Wide-field retinal mosaic image. 200° FOV:
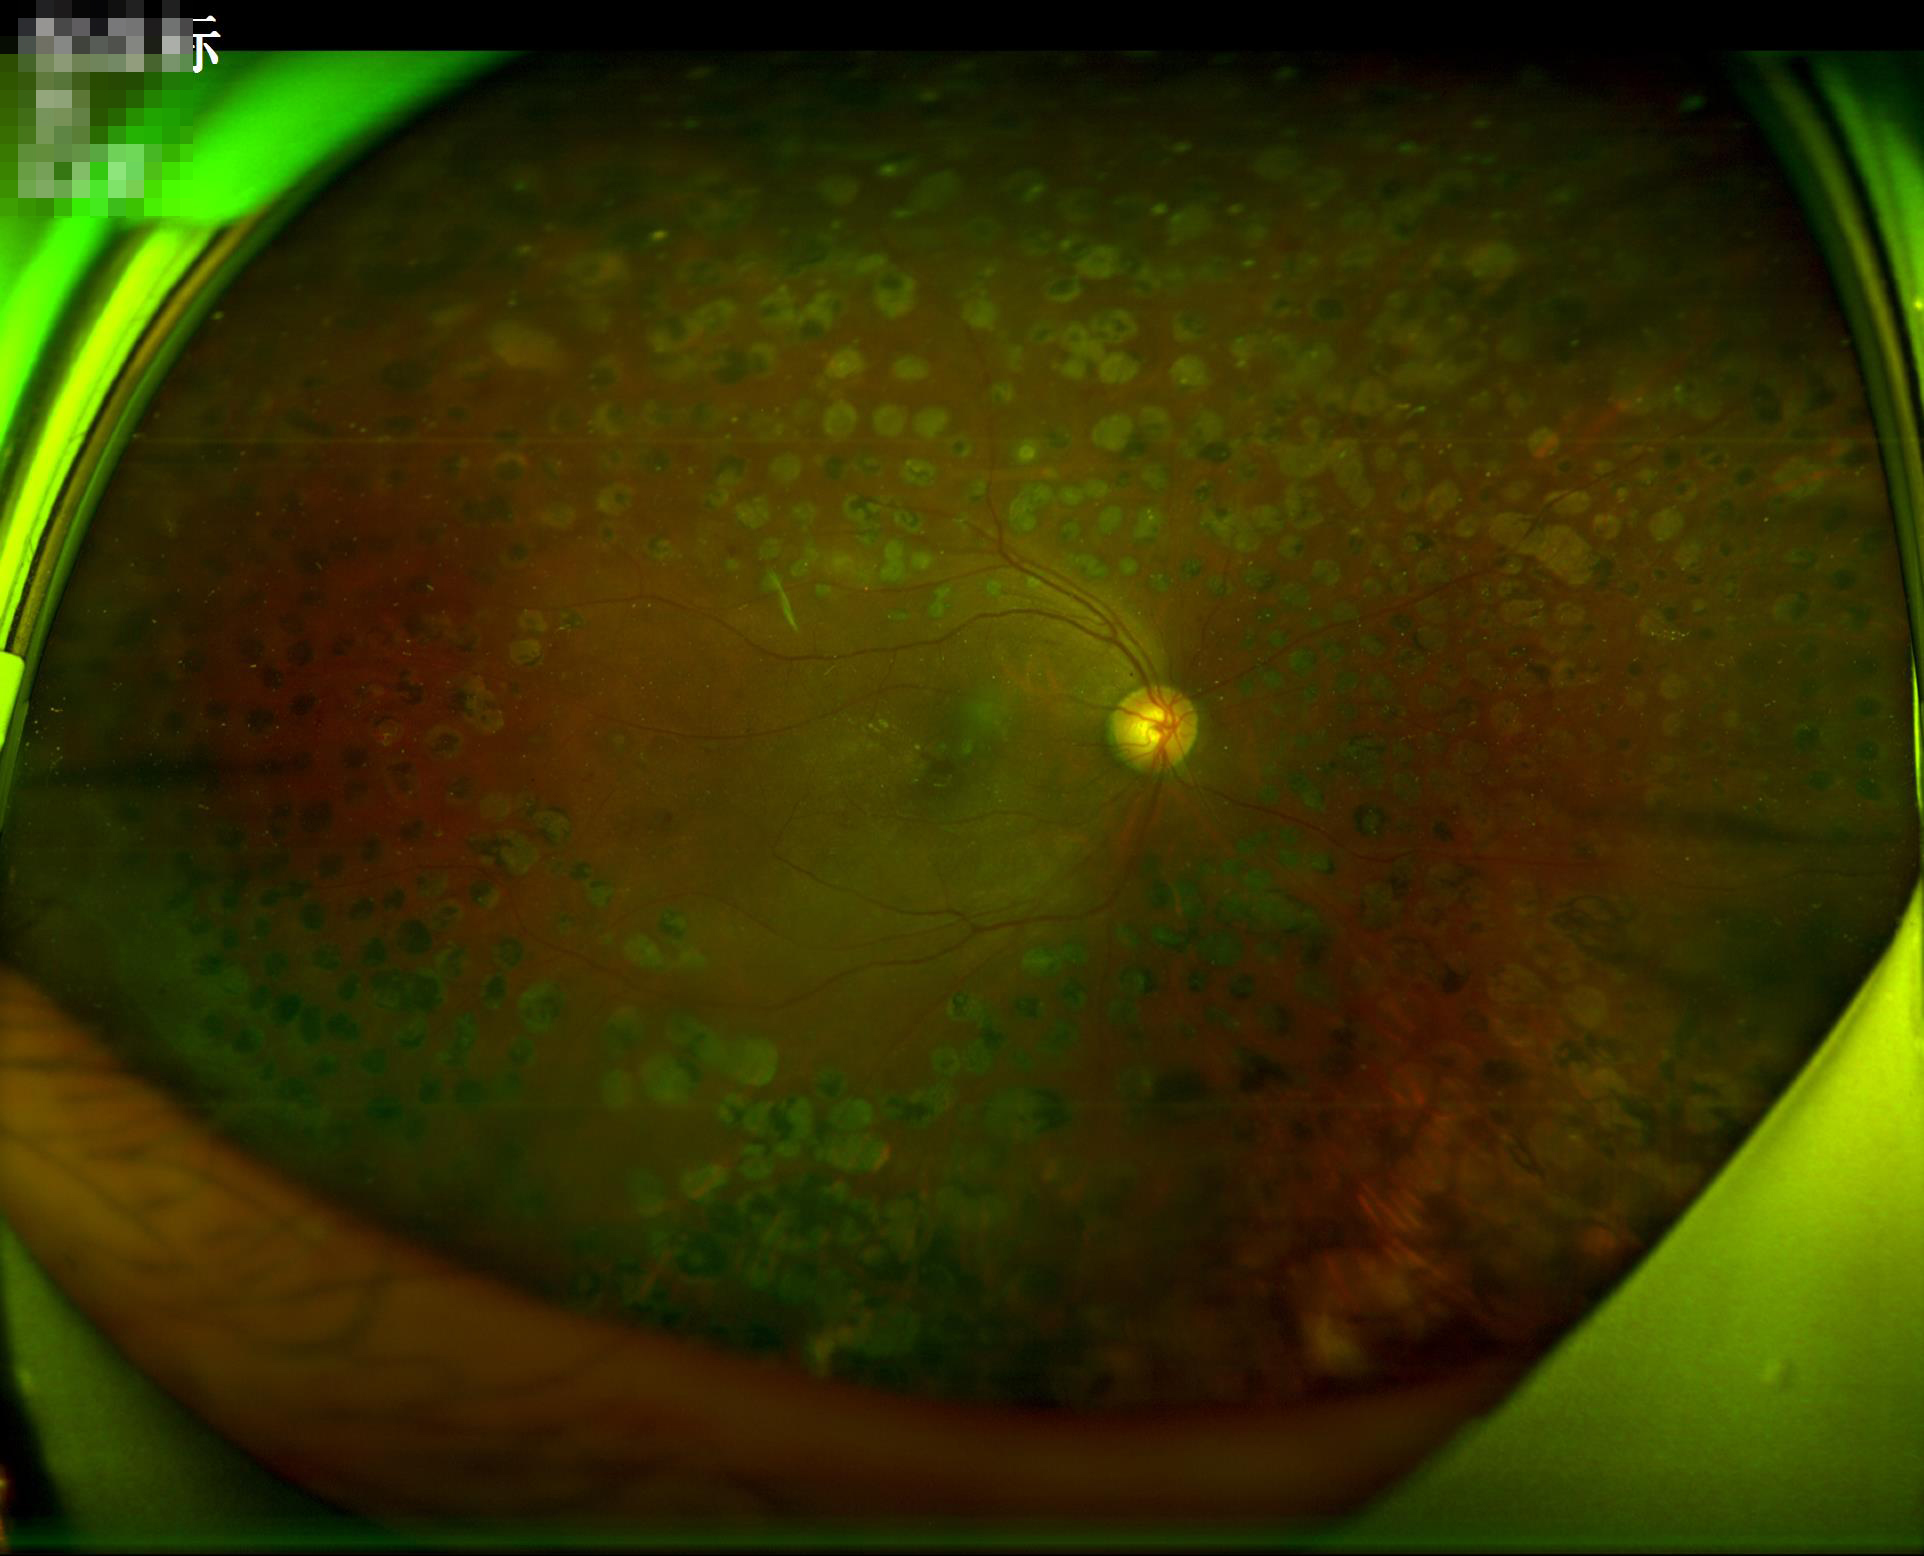
Image is sharp throughout the field. Even illumination with no color cast. Overall image quality is good. Adequate contrast for distinguishing structures.